Wide-field fundus image from infant ROP screening.
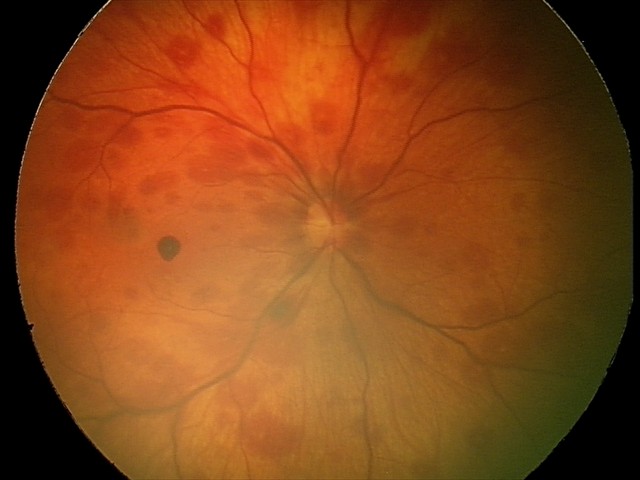

Impression: retinal hemorrhages.